Modified Davis classification
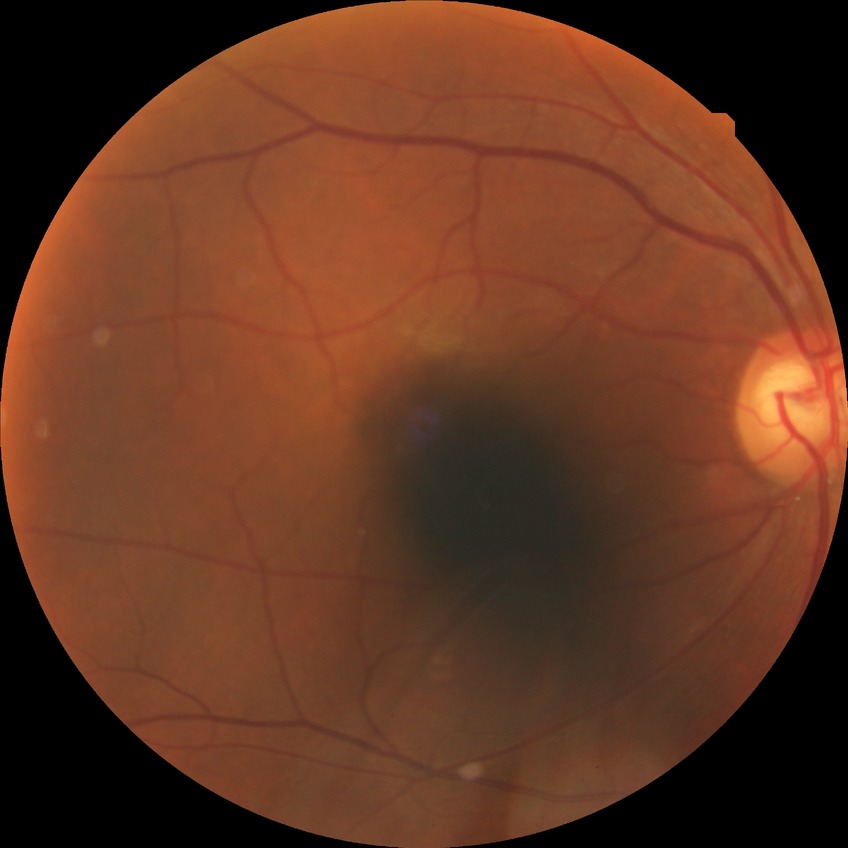
Davis grading: no diabetic retinopathy.